Infant wide-field retinal image · 1240 by 1240 pixels · Phoenix ICON, 100° FOV: 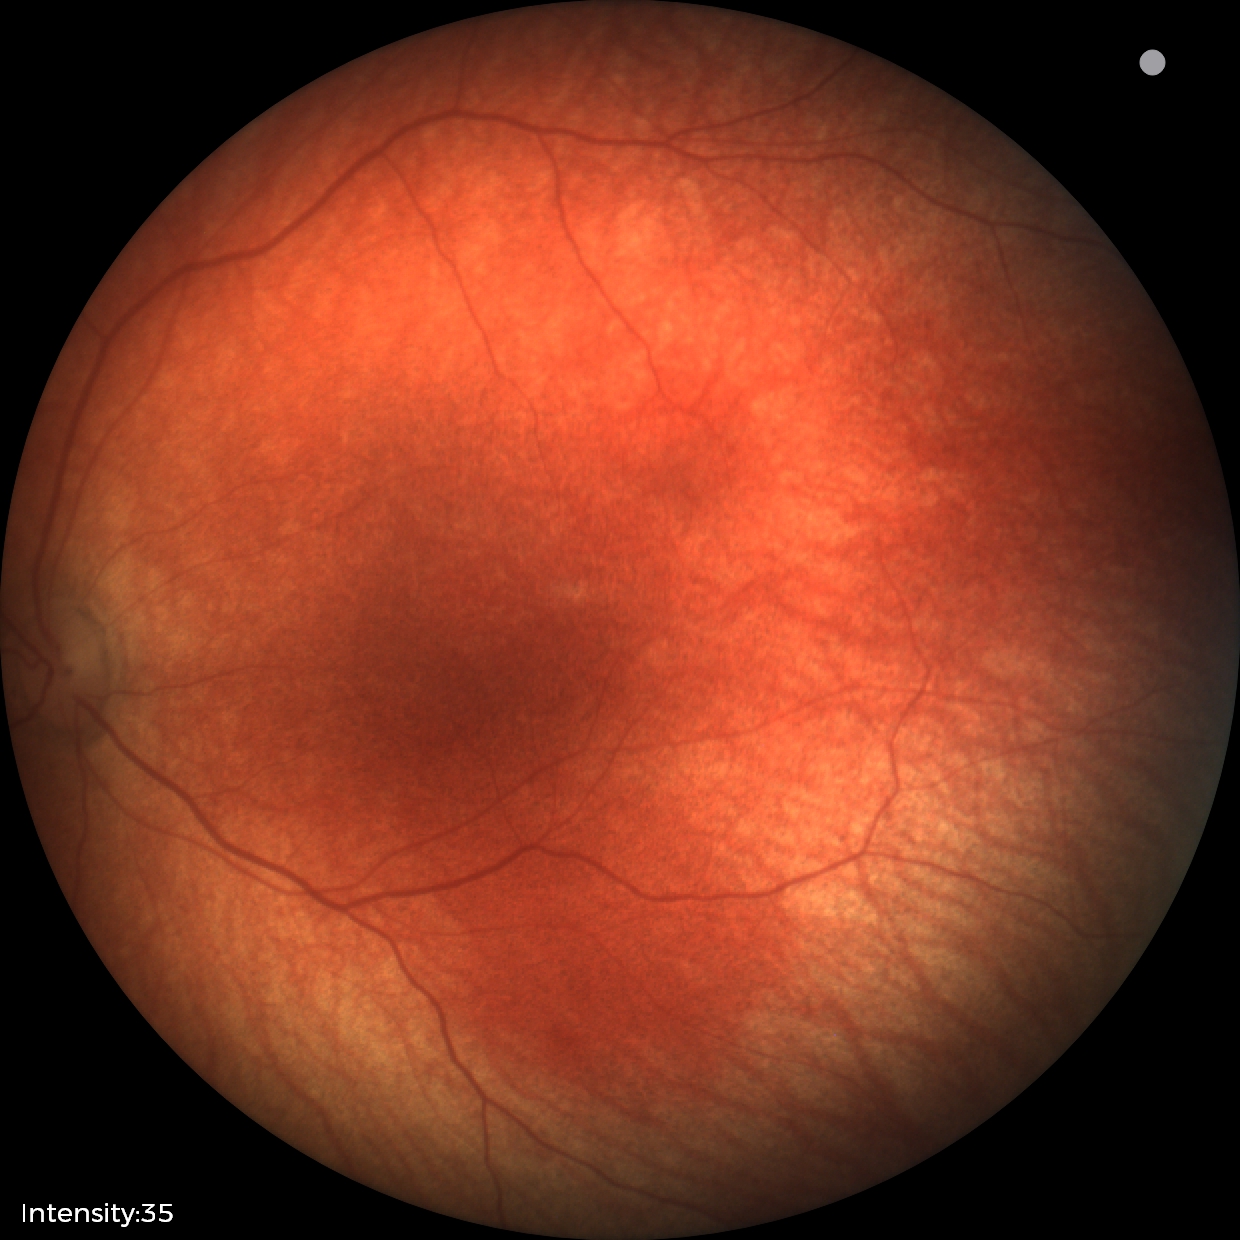 Diagnosis = no abnormalities